Wide-field fundus photograph from neonatal ROP screening. Camera: Natus RetCam Envision (130° FOV):
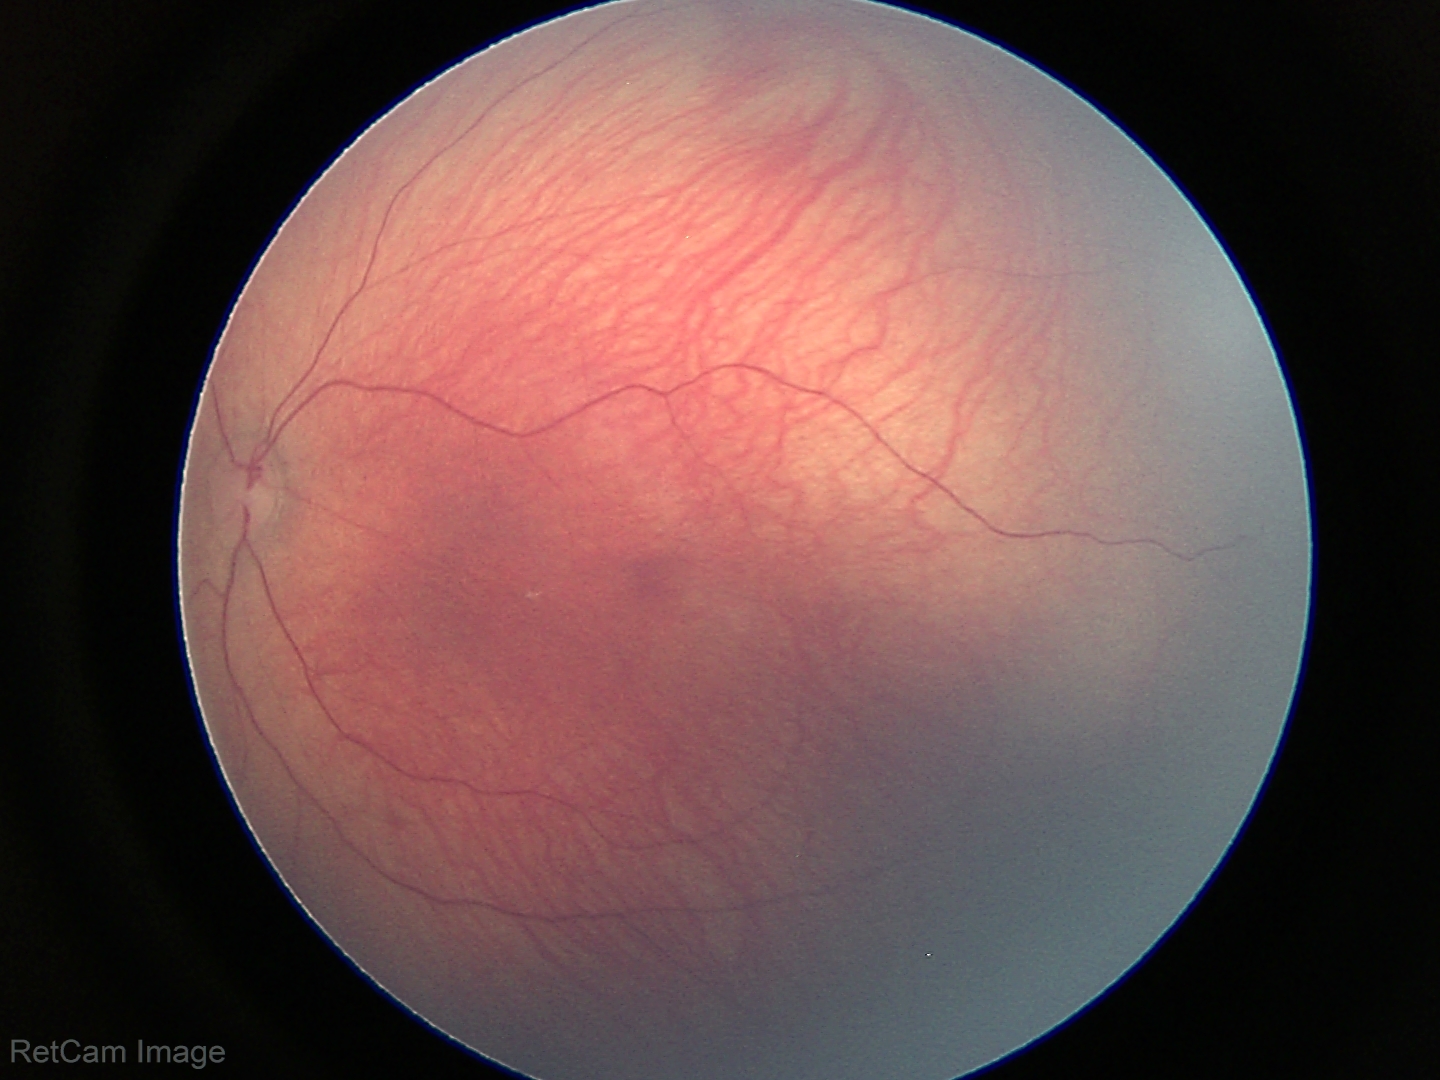
Screening examination with no abnormal retinal findings.